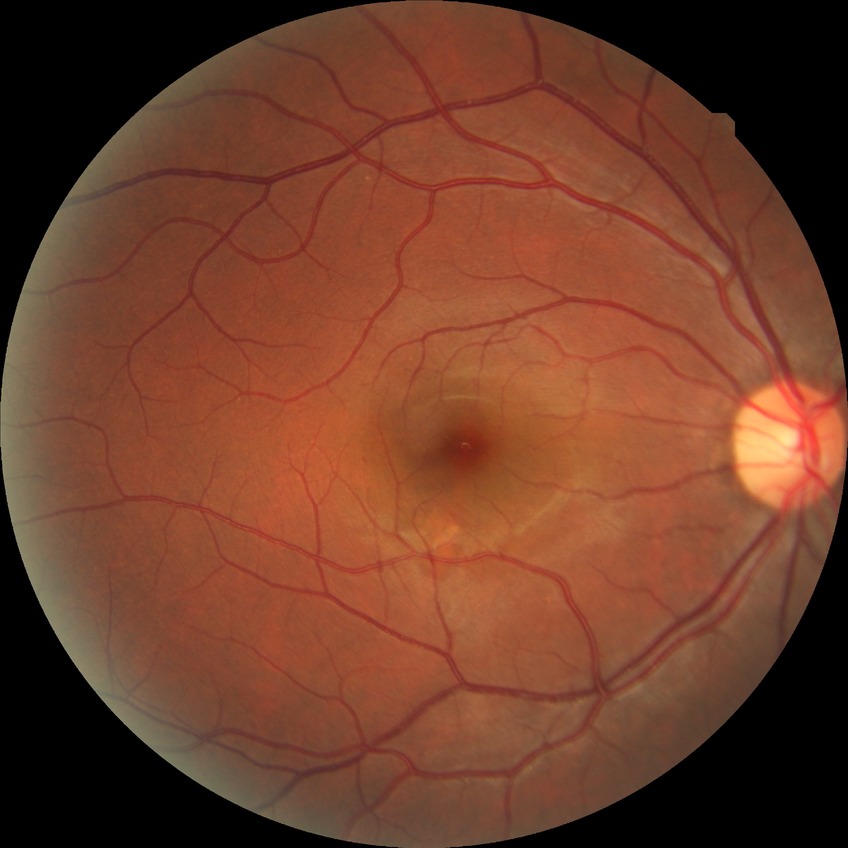

retinopathy stage = no diabetic retinopathy.